Retinal fundus photograph · 45° FOV — 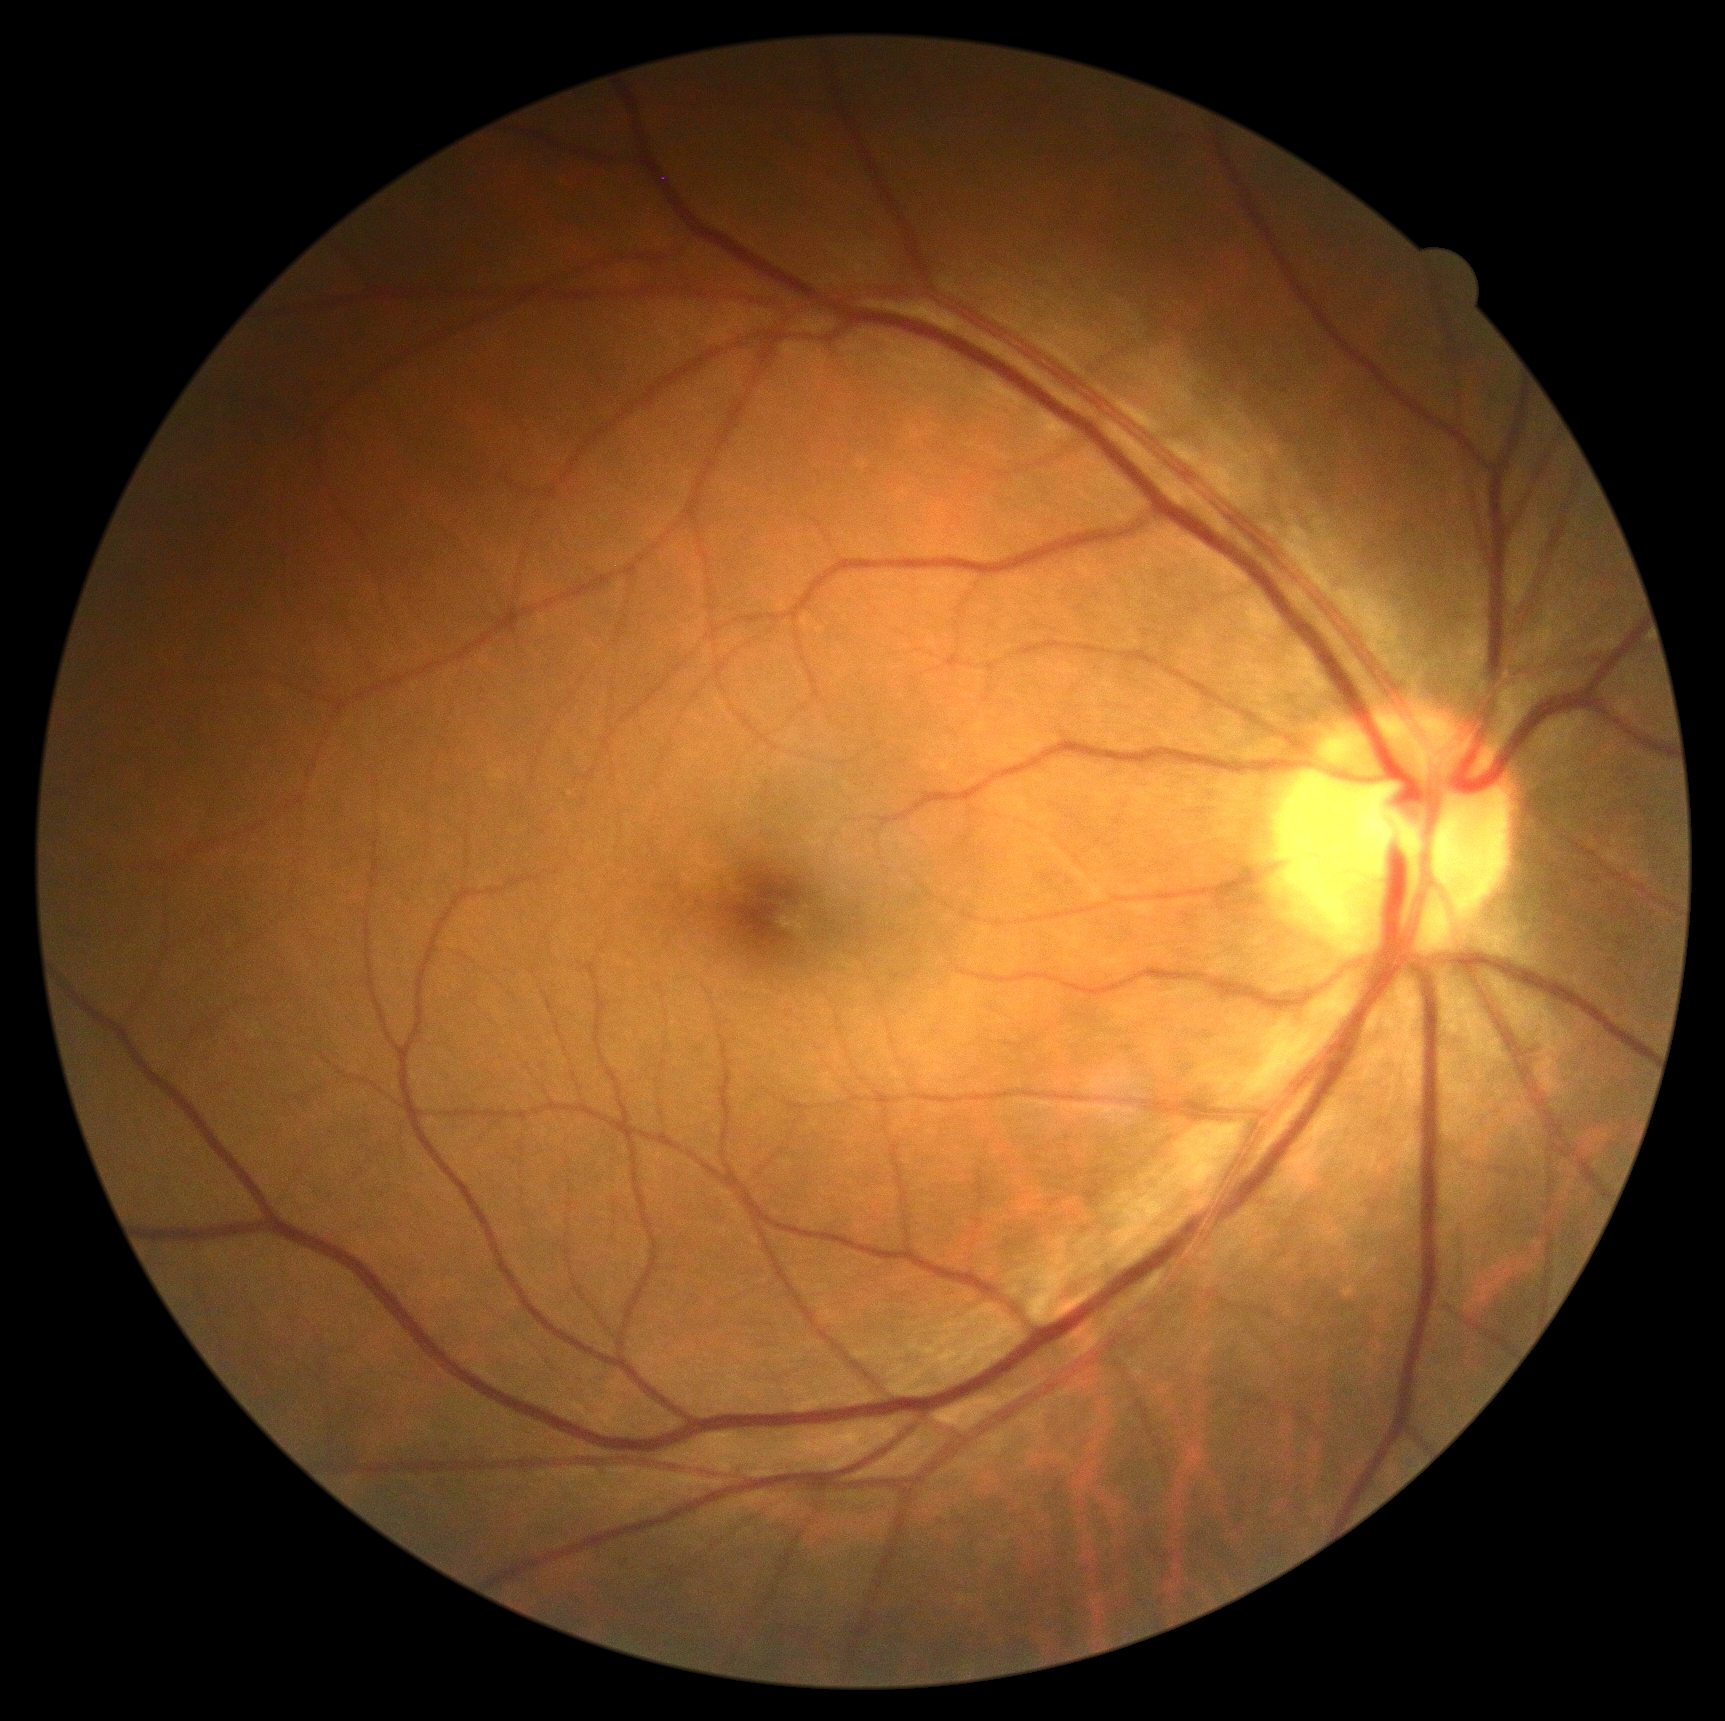

dr_grade: 0